Color fundus image · image size 848x848 · NIDEK AFC-230 · 45° field of view · without pupil dilation:
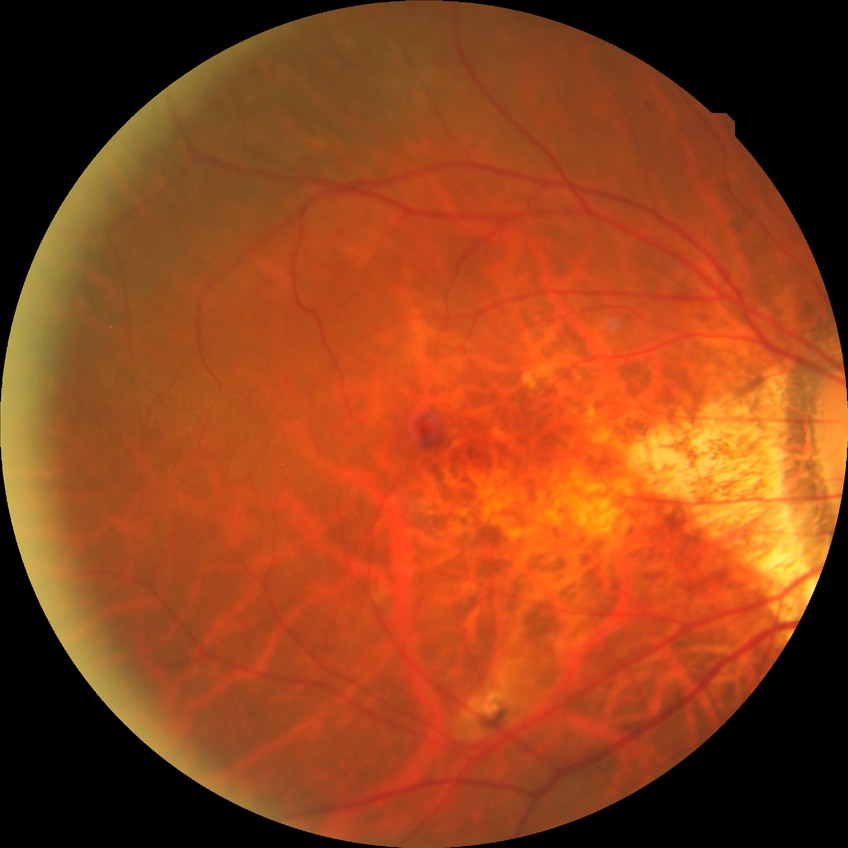 diabetic retinopathy stage = simple diabetic retinopathy.